Pediatric retinal photograph (wide-field).
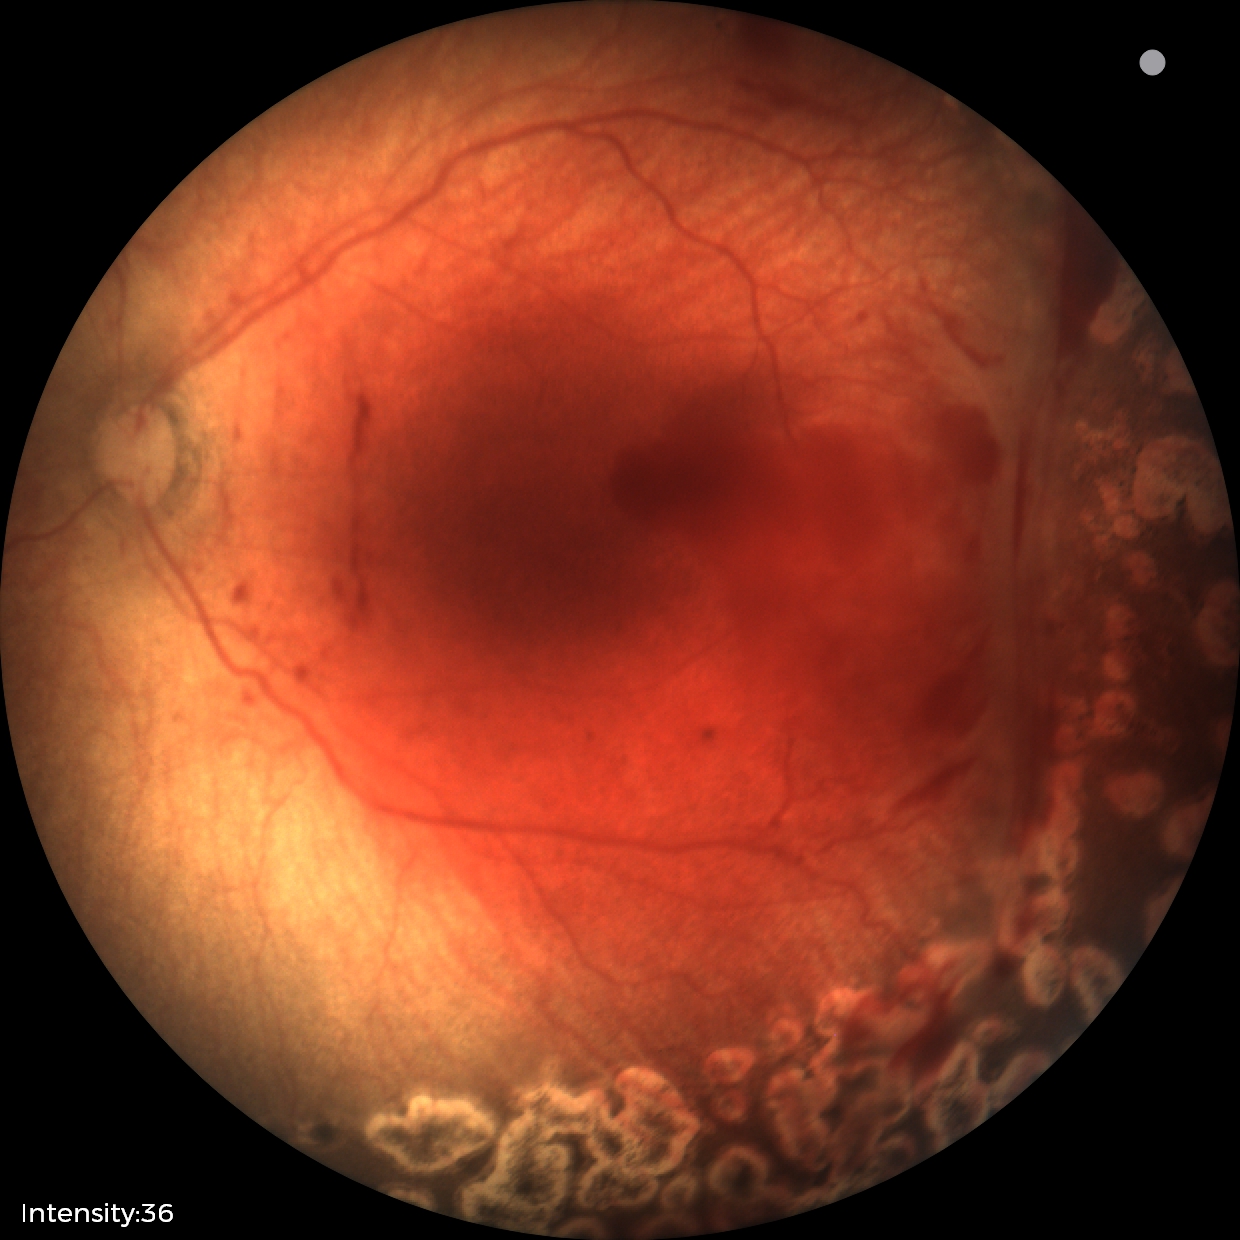 Screening examination consistent with status post retinopathy of prematurity.
No plus disease.